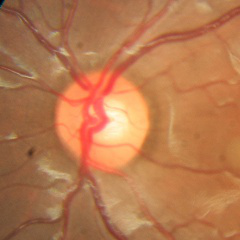
Diagnosis = no signs of glaucoma.